CFP:
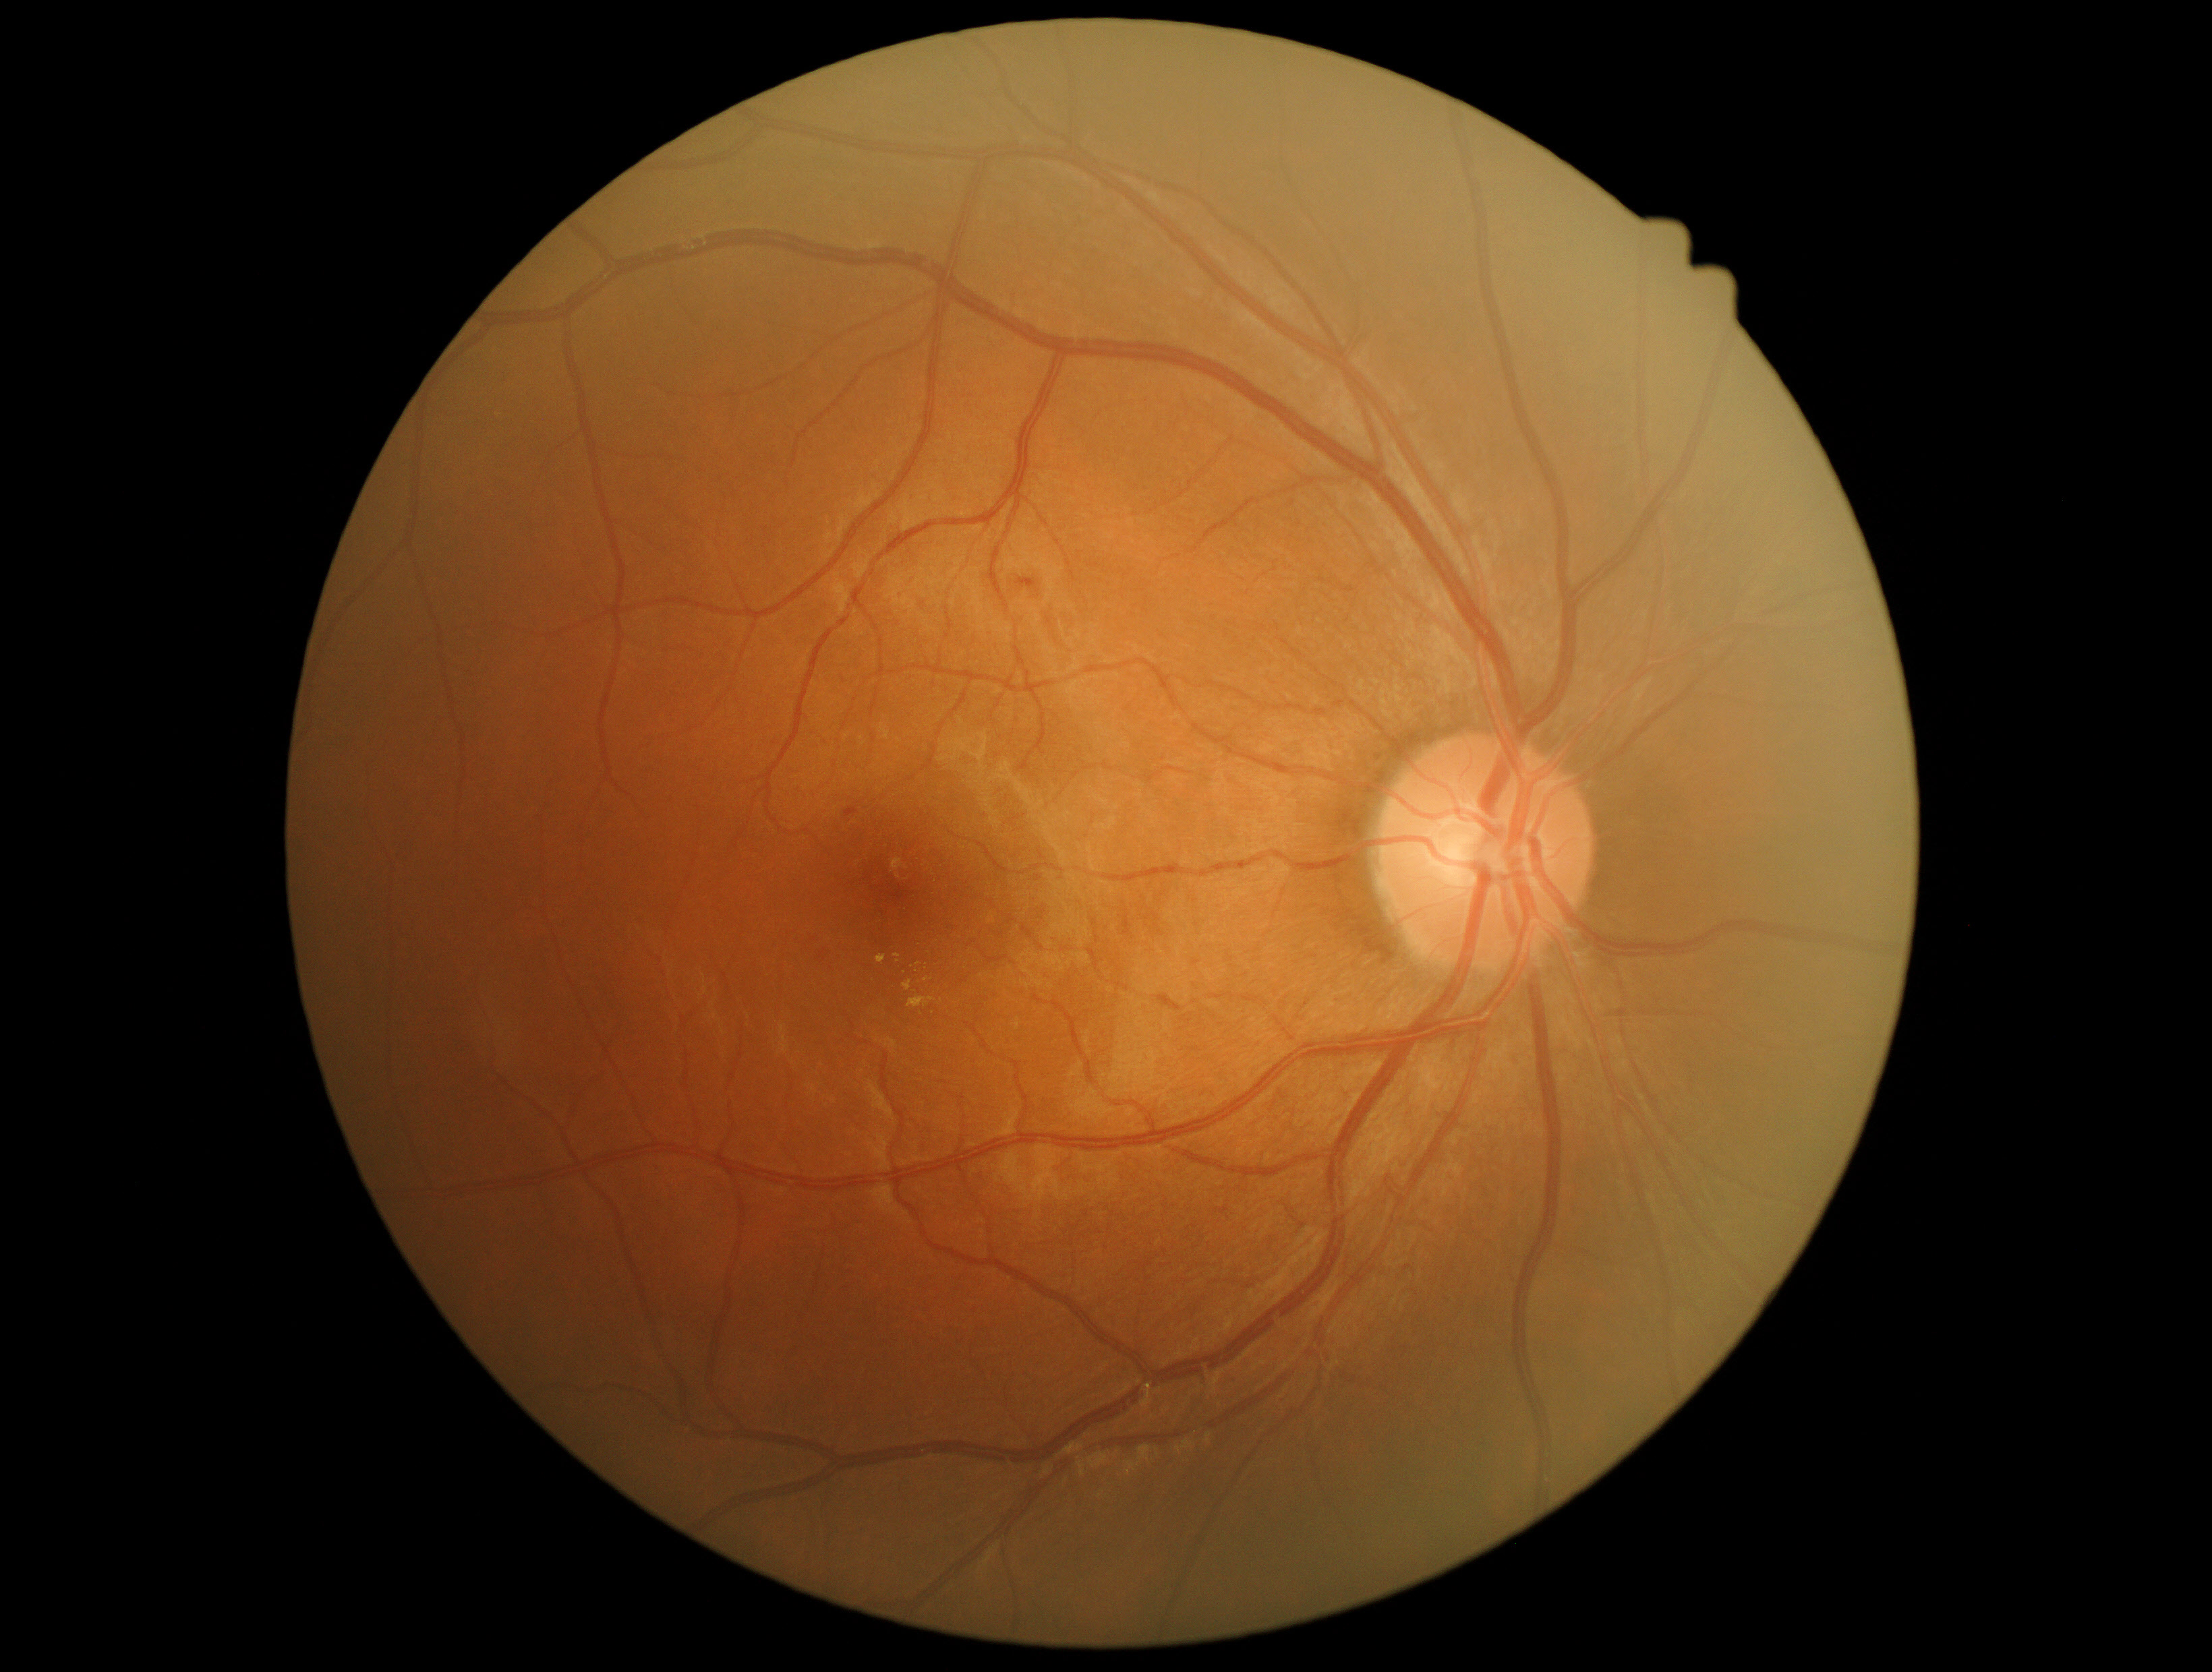 {
  "dr_grade": "2"
}